Fundus photo — 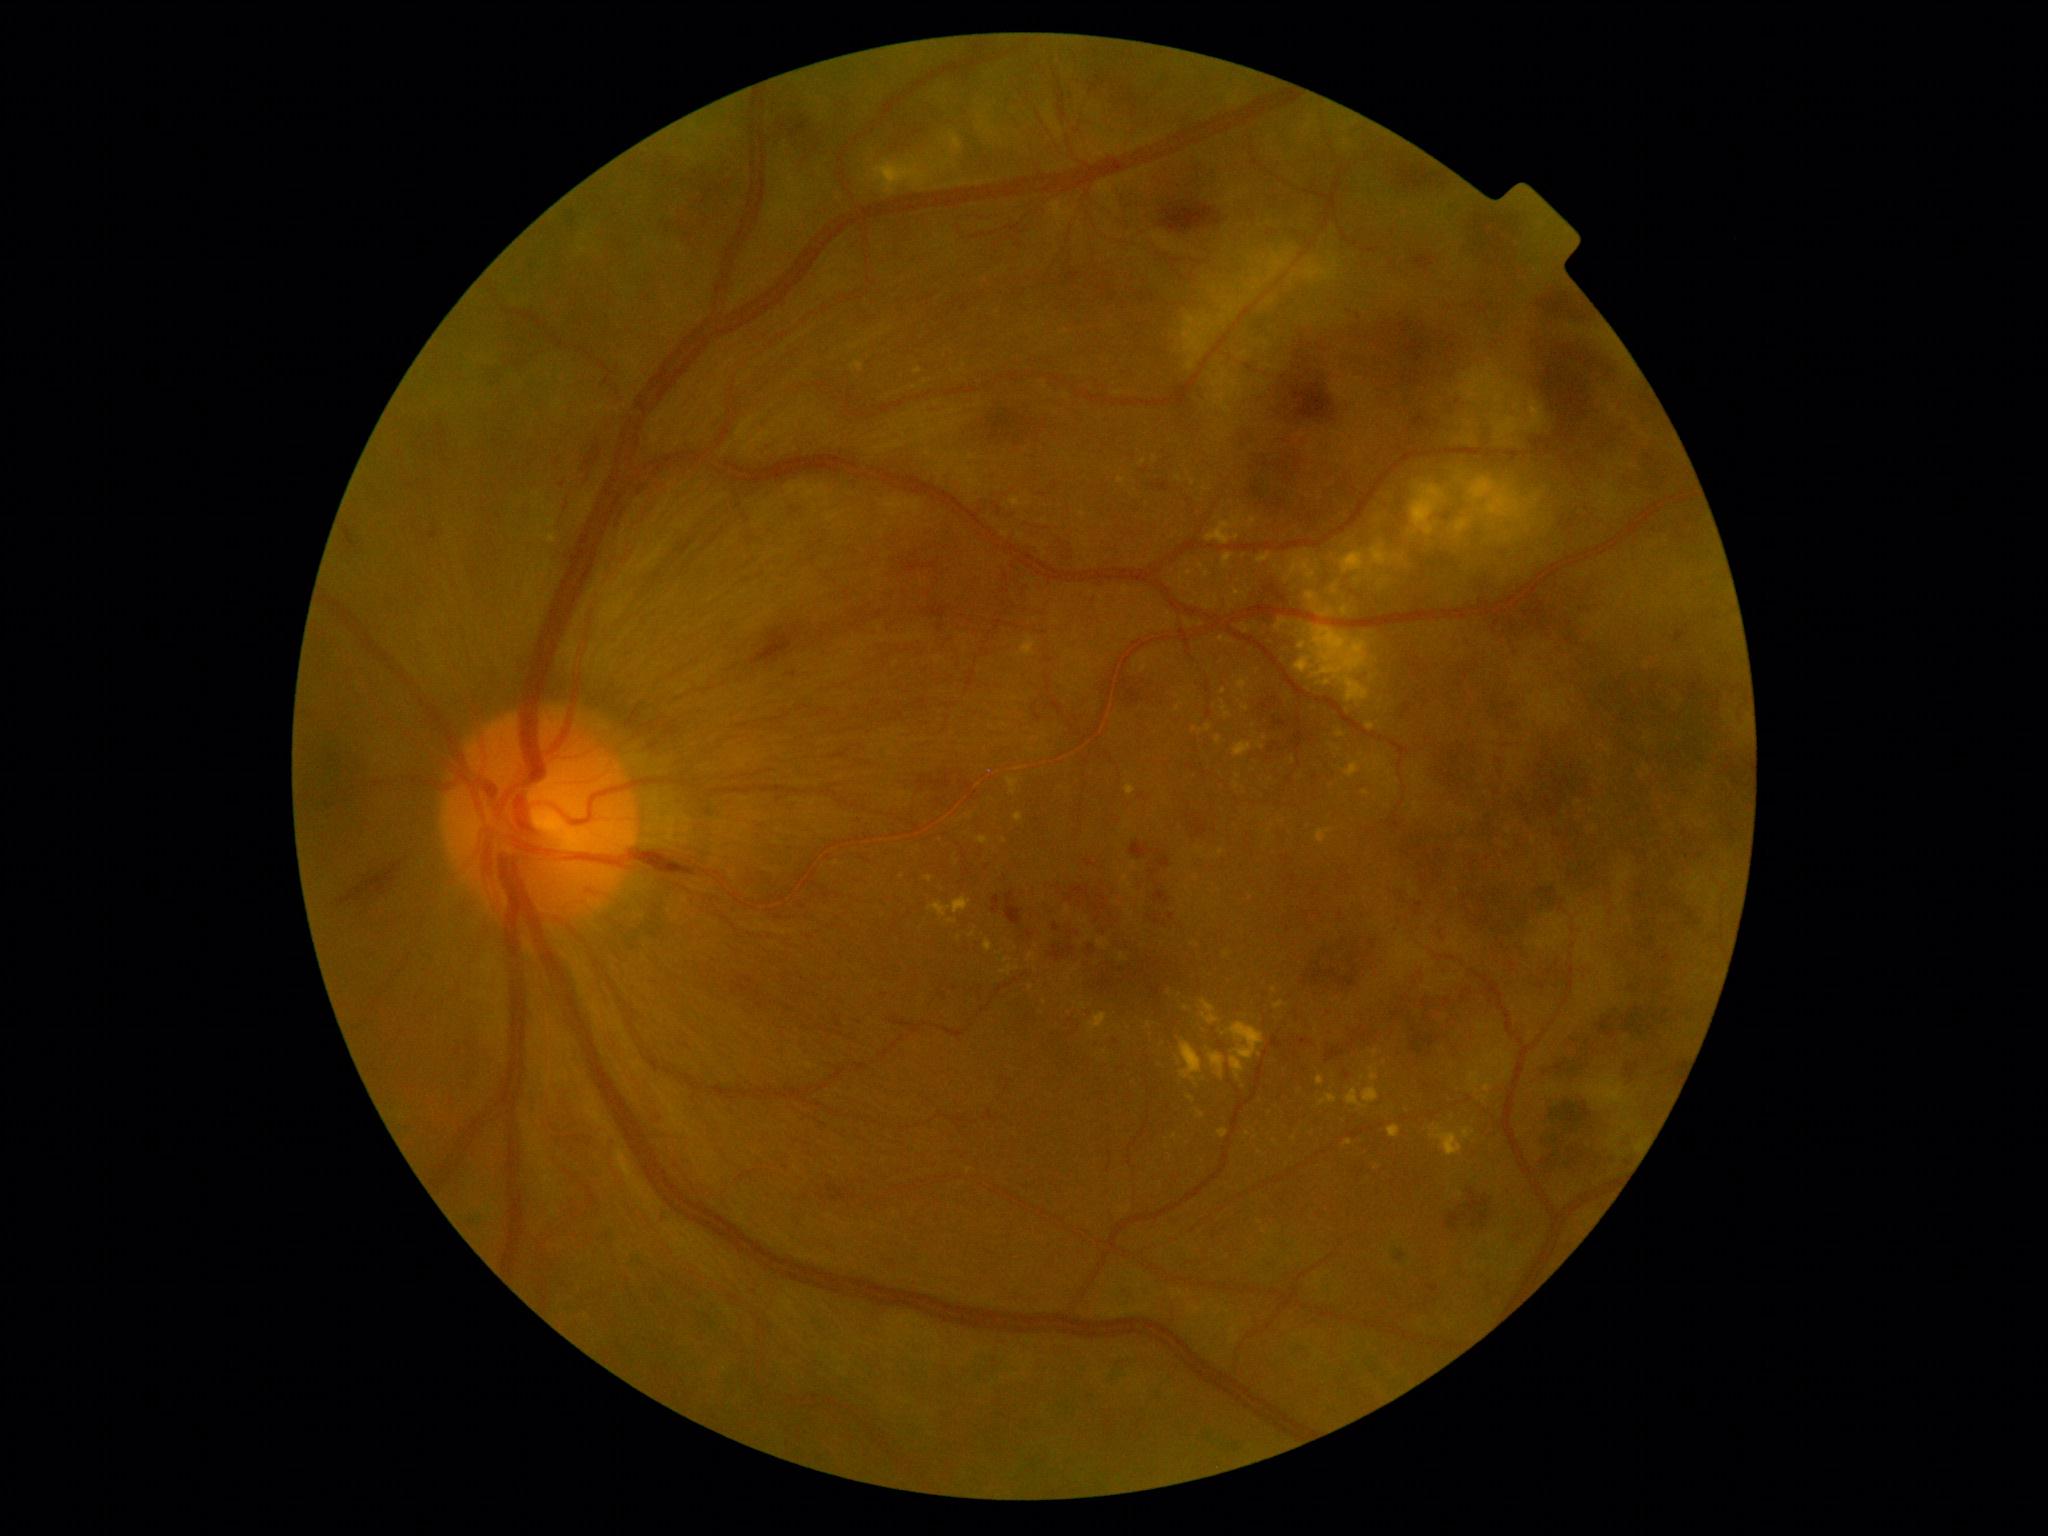
Diabetic retinopathy (DR) is grade 4 (PDR) — neovascularization and/or vitreous/pre-retinal hemorrhage
A subset of detected lesions:
microaneurysms (MAs) (more not shown): bbox=[1270, 1037, 1284, 1050] | bbox=[1244, 554, 1257, 563] | bbox=[1299, 1038, 1313, 1045]
MAs (small, approximate centers) near [1070,1020] | [1116,1041] | [563,485]
hemorrhages (HEs) (more not shown): bbox=[721, 978, 810, 1035] | bbox=[1154, 192, 1244, 233] | bbox=[789, 504, 817, 523] | bbox=[1412, 256, 1436, 274] | bbox=[981, 402, 1045, 451] | bbox=[436, 431, 448, 438] | bbox=[949, 292, 978, 318] | bbox=[903, 760, 995, 825] | bbox=[1406, 1012, 1461, 1062] | bbox=[1541, 1001, 1693, 1083] | bbox=[1385, 1247, 1415, 1269] | bbox=[1406, 573, 1751, 989] | bbox=[663, 87, 941, 255] | bbox=[628, 851, 714, 875]
HEs (small, approximate centers) near [432,436]
hard exudates (EXs) (more not shown): bbox=[1180, 1040, 1203, 1081] | bbox=[1198, 725, 1213, 735] | bbox=[1257, 742, 1264, 750] | bbox=[1257, 364, 1557, 825] | bbox=[1317, 829, 1332, 843] | bbox=[1250, 517, 1257, 527] | bbox=[978, 836, 989, 845] | bbox=[1018, 636, 1037, 657] | bbox=[1080, 919, 1088, 924] | bbox=[1009, 497, 1022, 507]
EXs (small, approximate centers) near [1183,580] | [1248,1134] | [1206,489] | [973,934] | [950,154] | [1105,1052] | [1195,729] | [1216,597]
soft exudates (SEs): absent